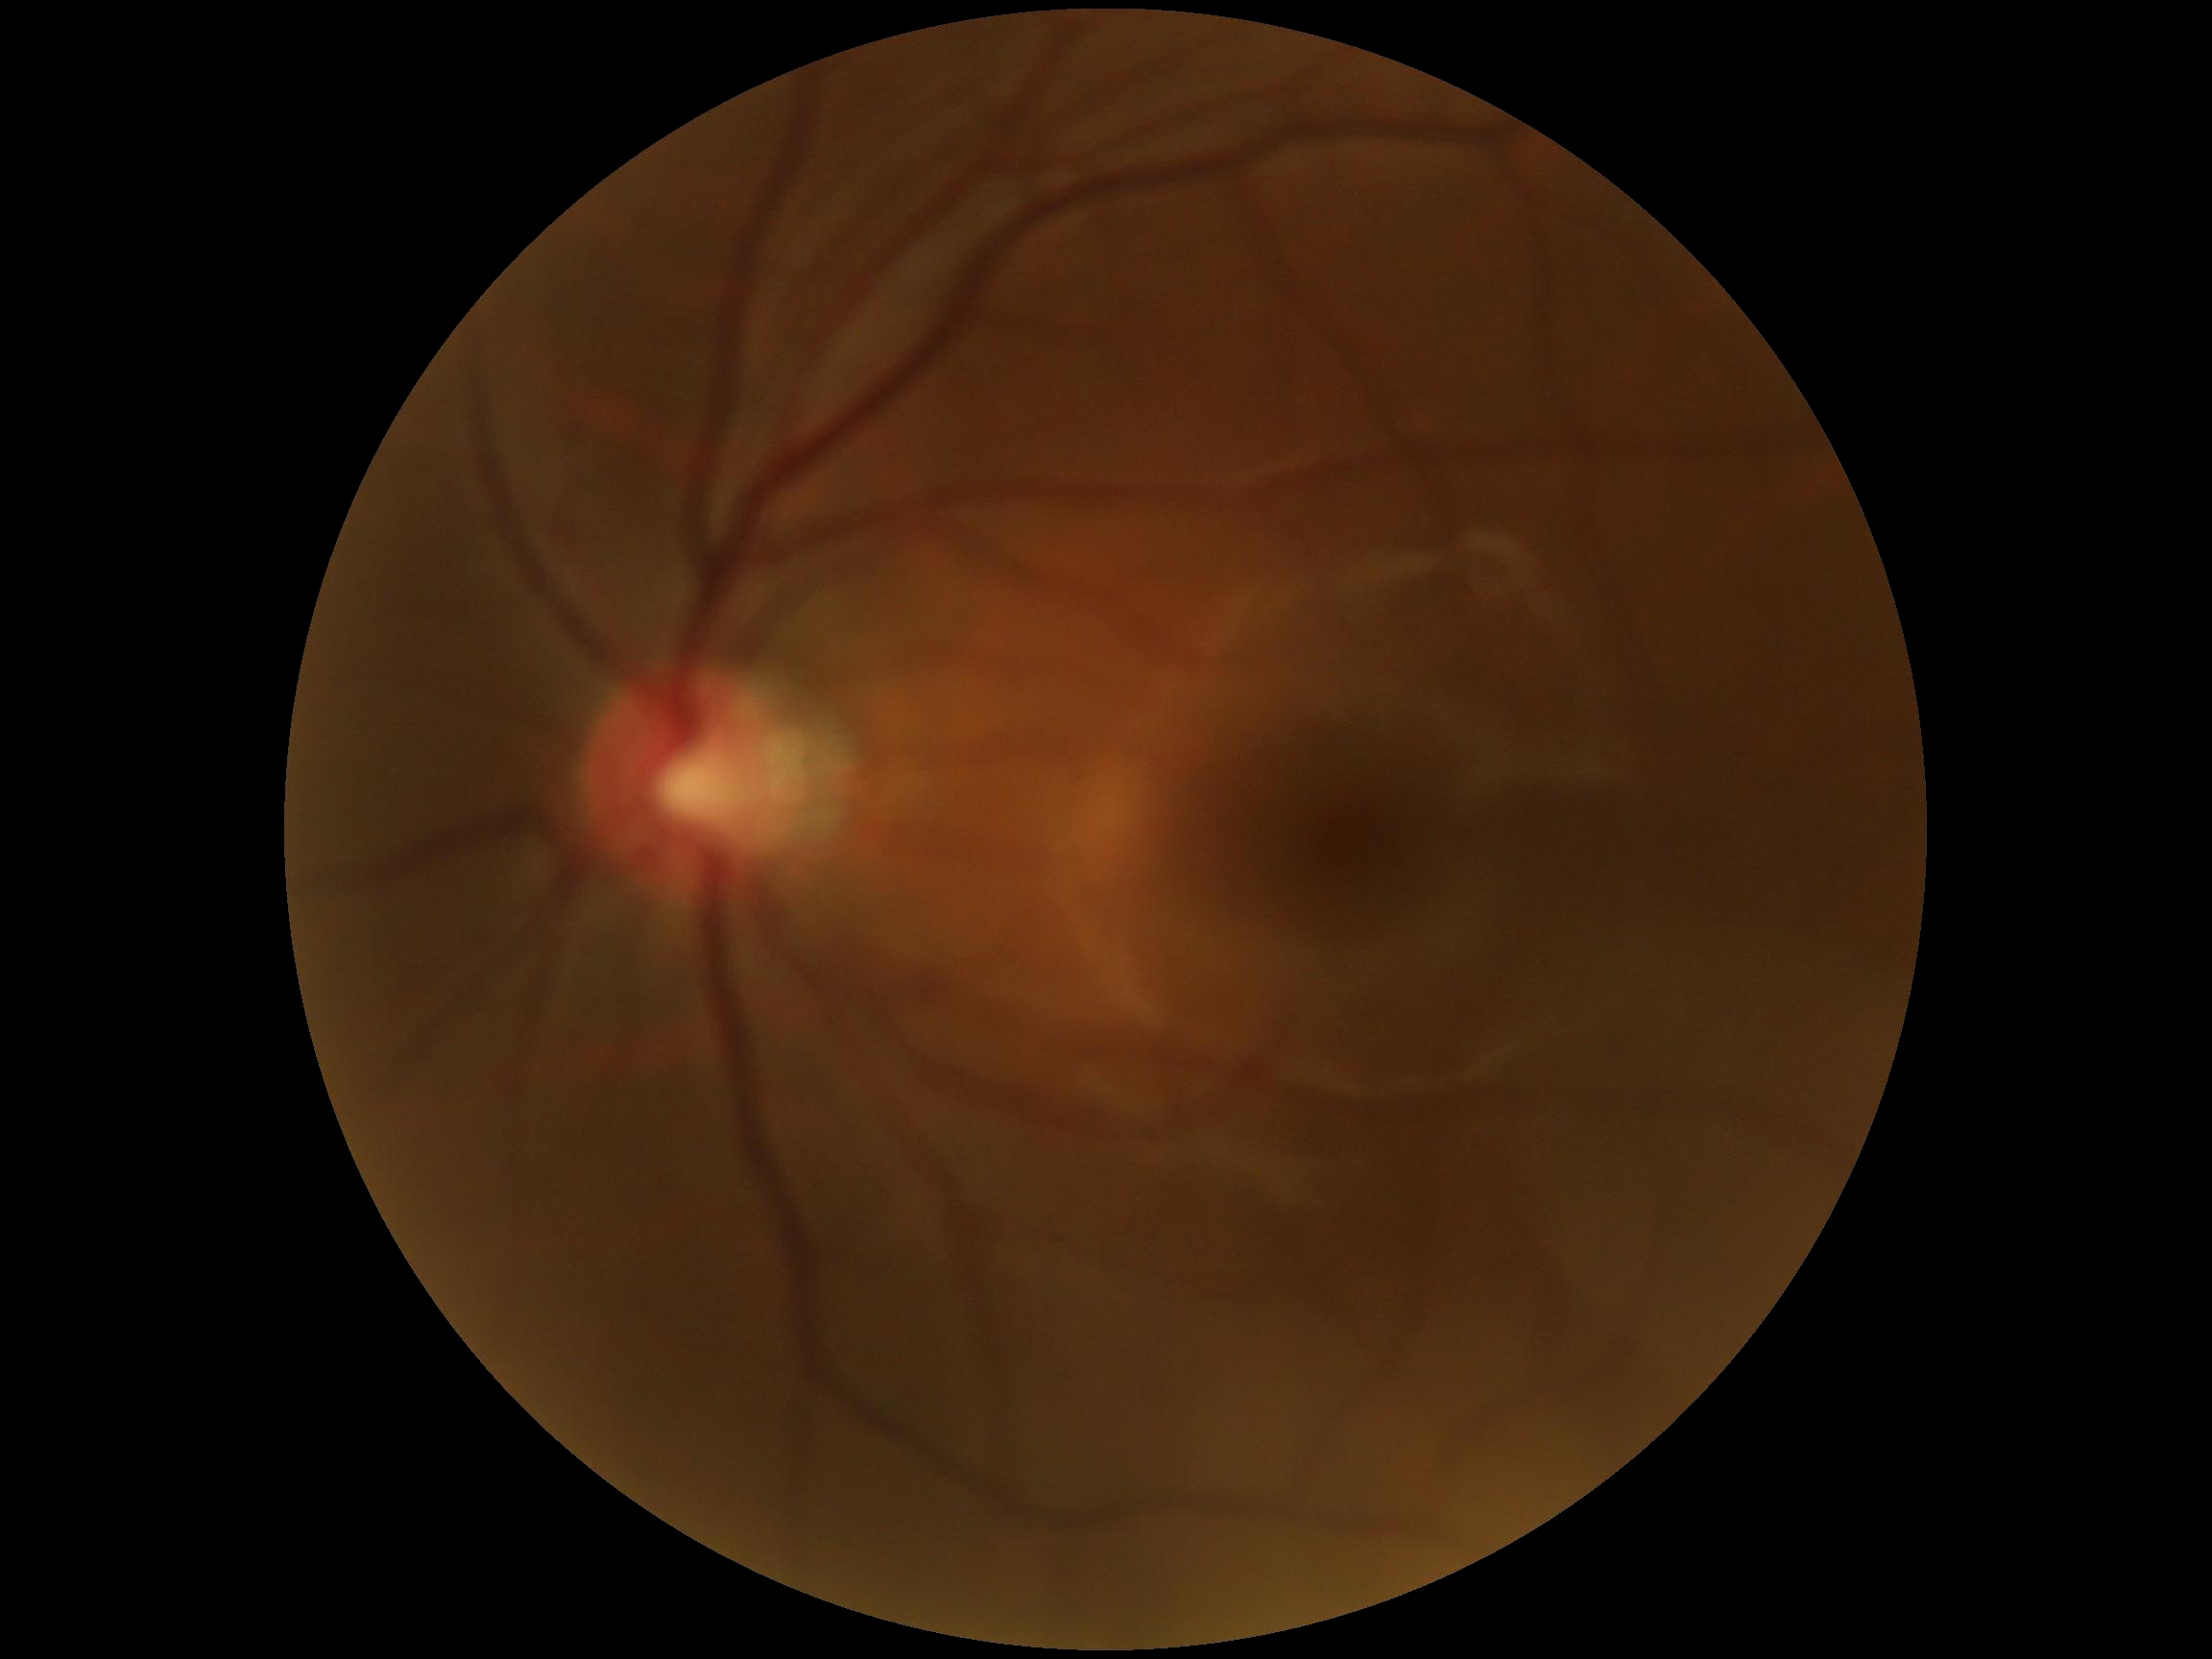 diabetic retinopathy (DR)=no apparent diabetic retinopathy (grade 0).